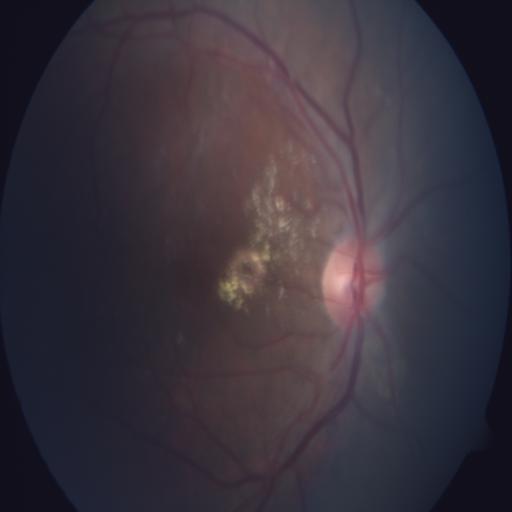

Abnormalities: exudation.